45-degree field of view: 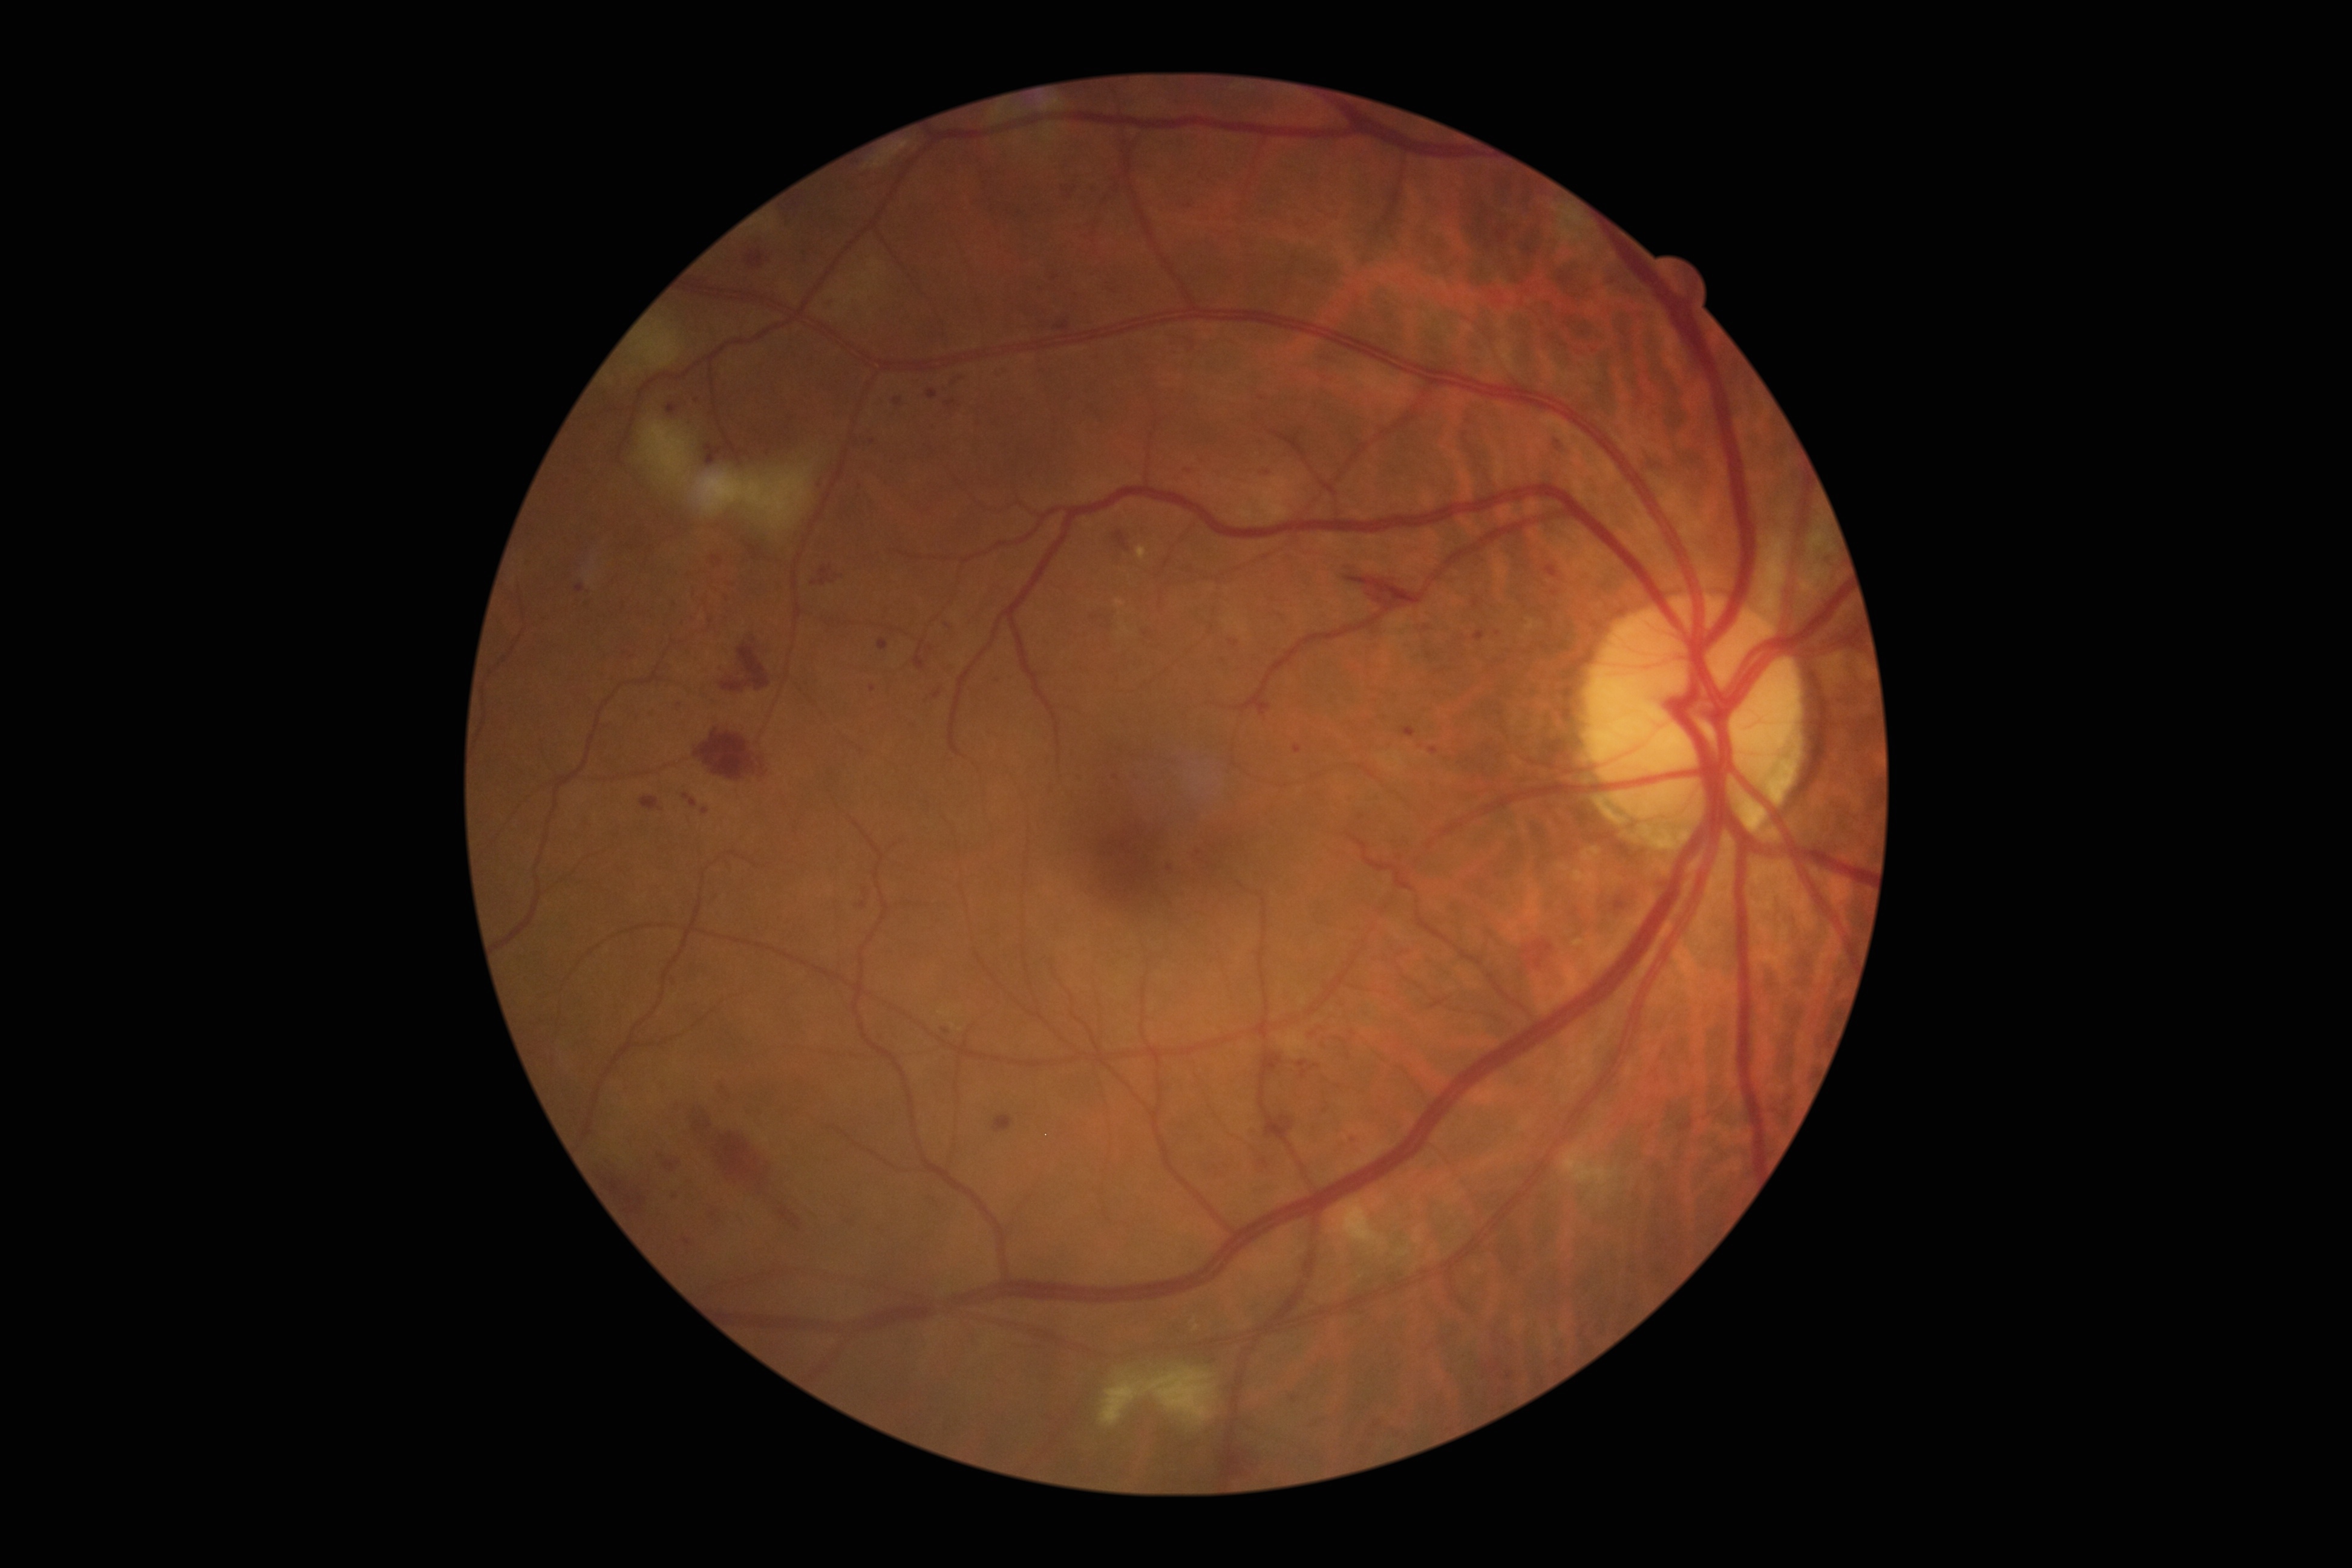 DR grade is 3 (severe NPDR).